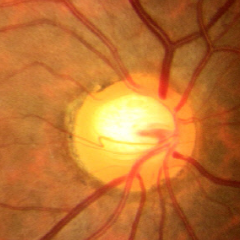
Glaucomatous changes are present. This fundus photograph shows early-stage glaucoma.